Image size 848x848, modified Davis grading, color fundus image, 45 degree fundus photograph, NIDEK AFC-230, nonmydriatic
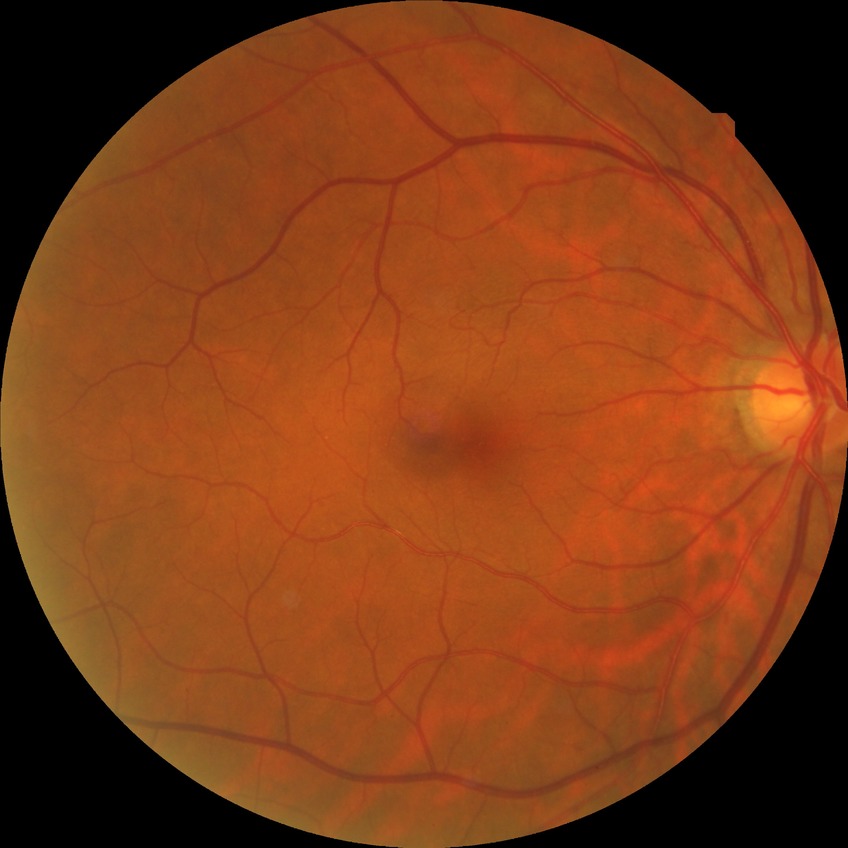
diabetic retinopathy severity@no diabetic retinopathy.